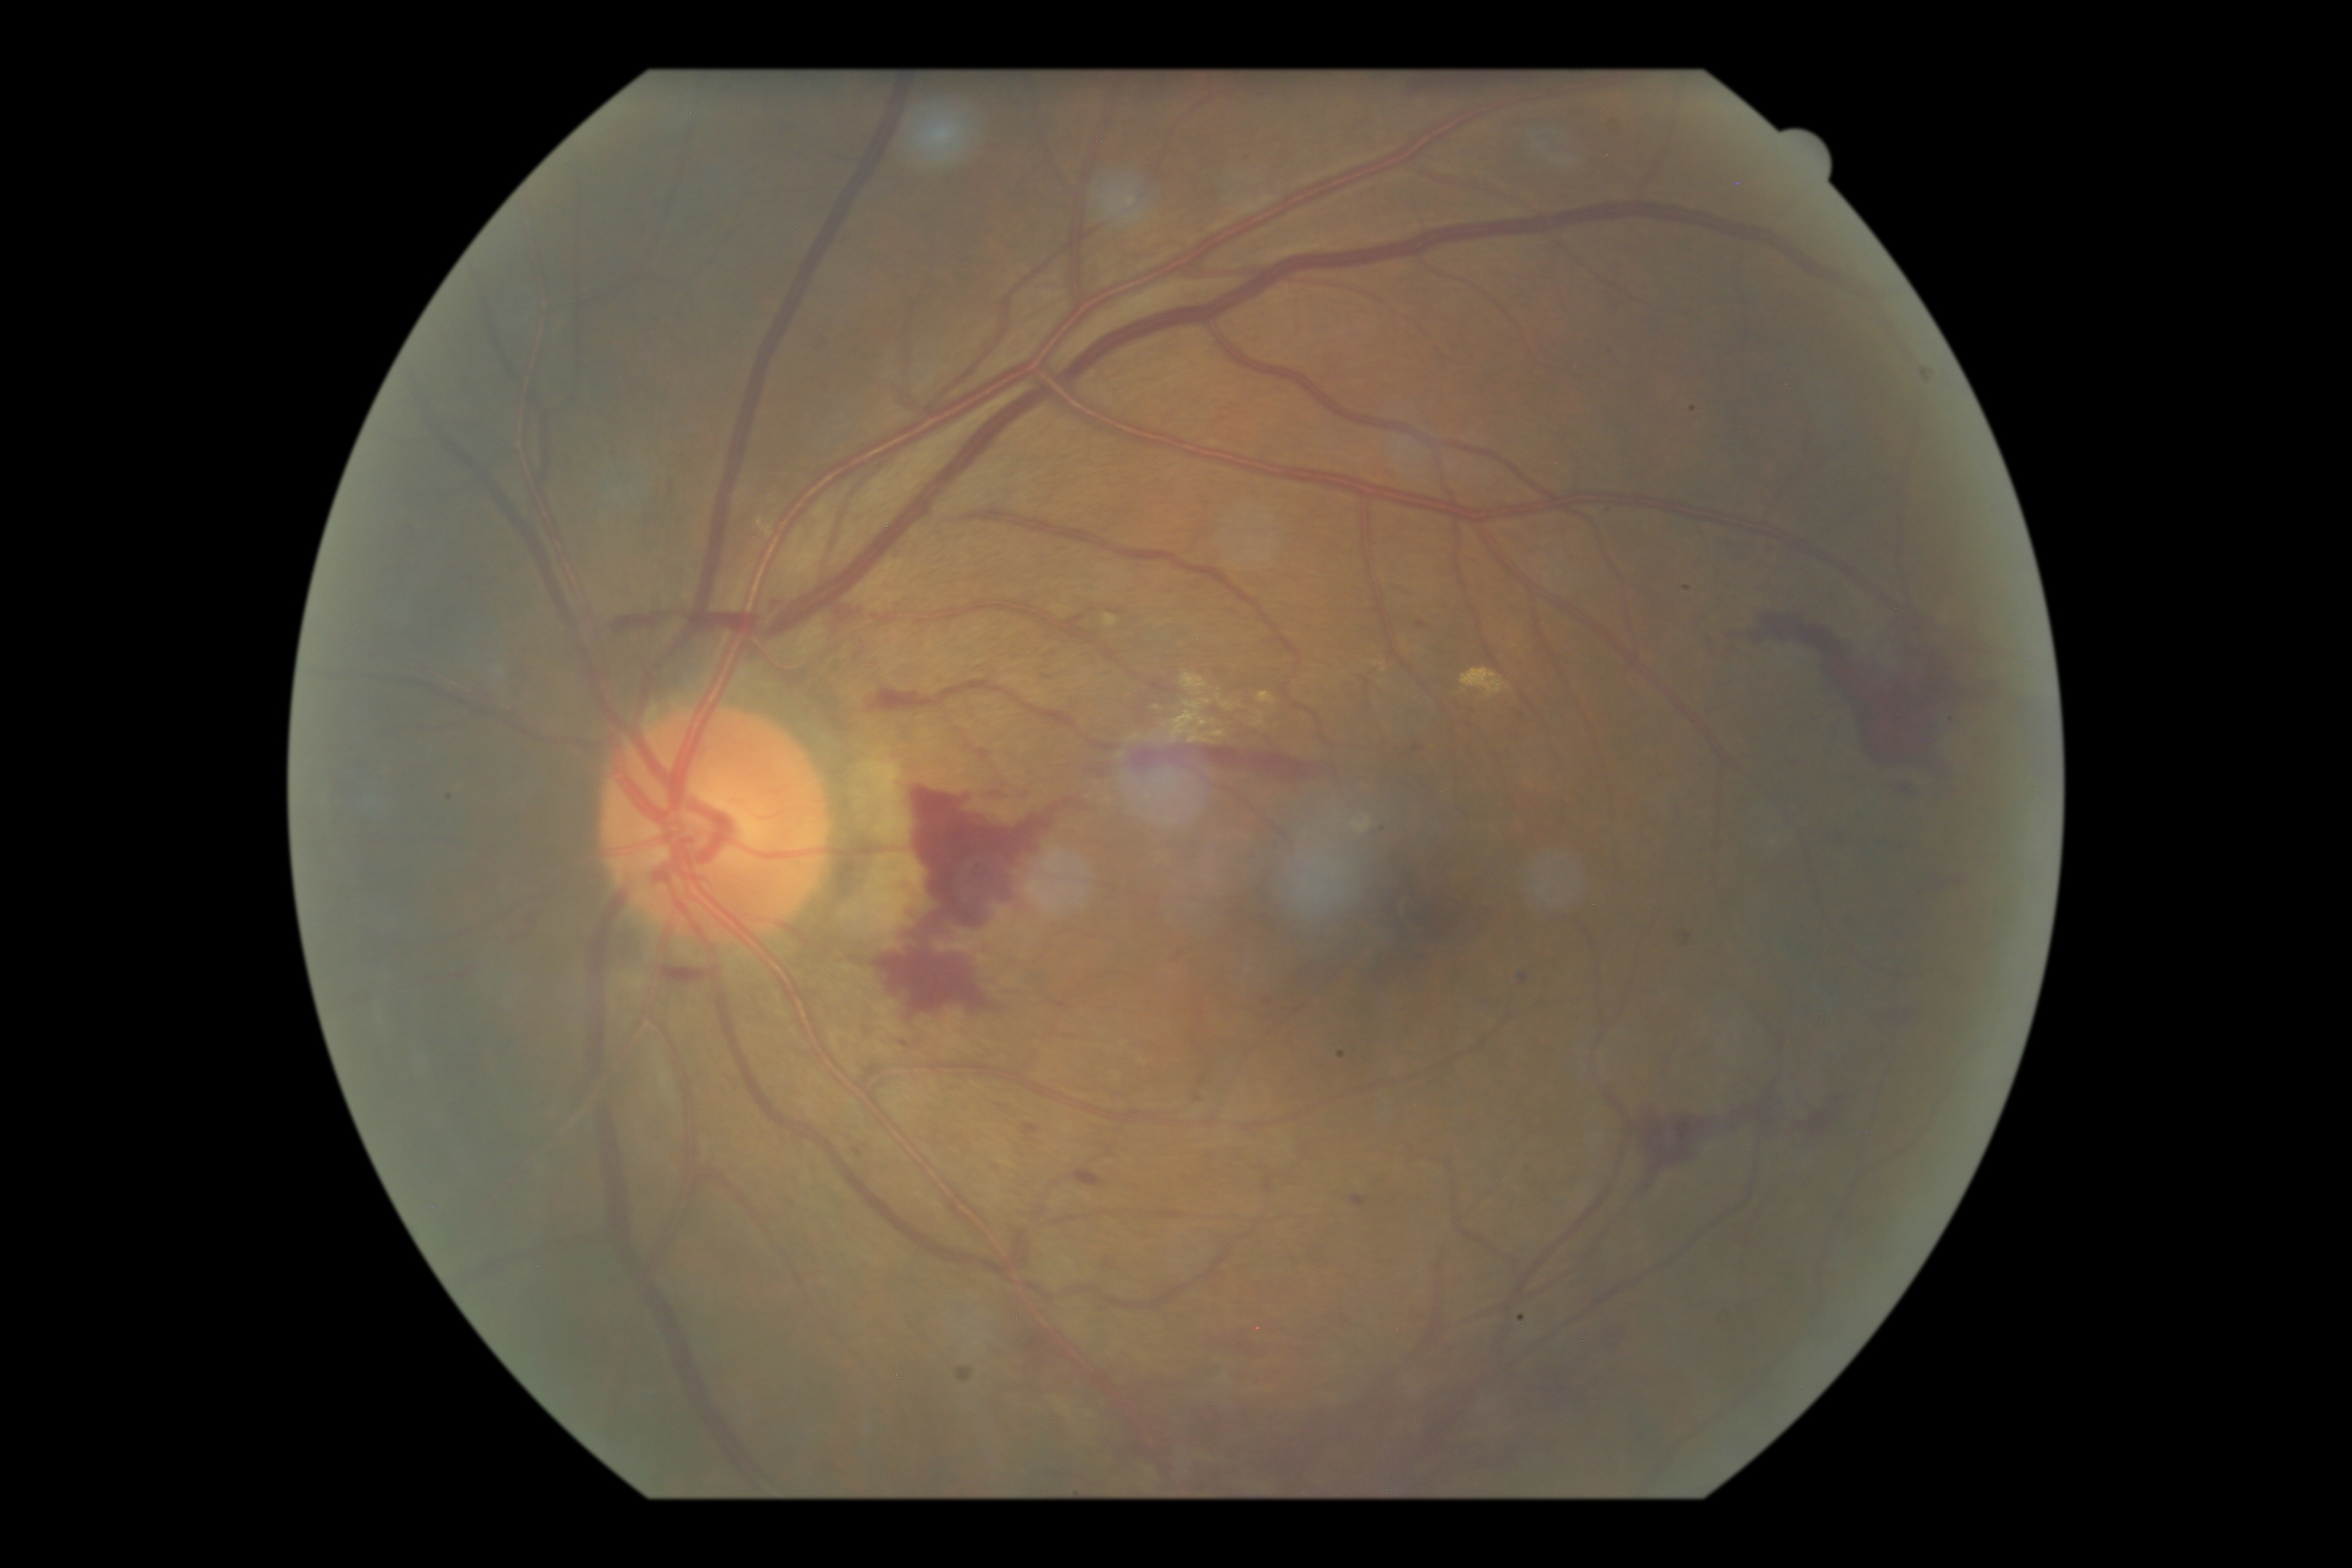 DR severity = PDR (grade 4) — neovascularization and/or vitreous/pre-retinal hemorrhage.